NIDEK AFC-230, 45° FOV — 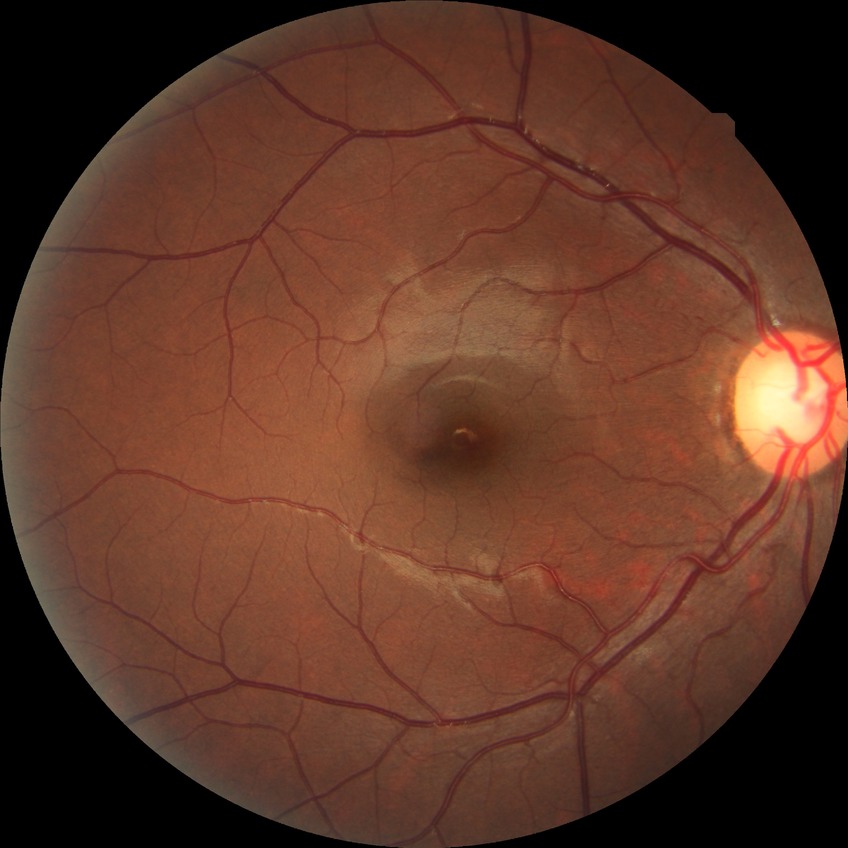
retinopathy grade=no diabetic retinopathy.